Fundus photo, FOV: 45 degrees: 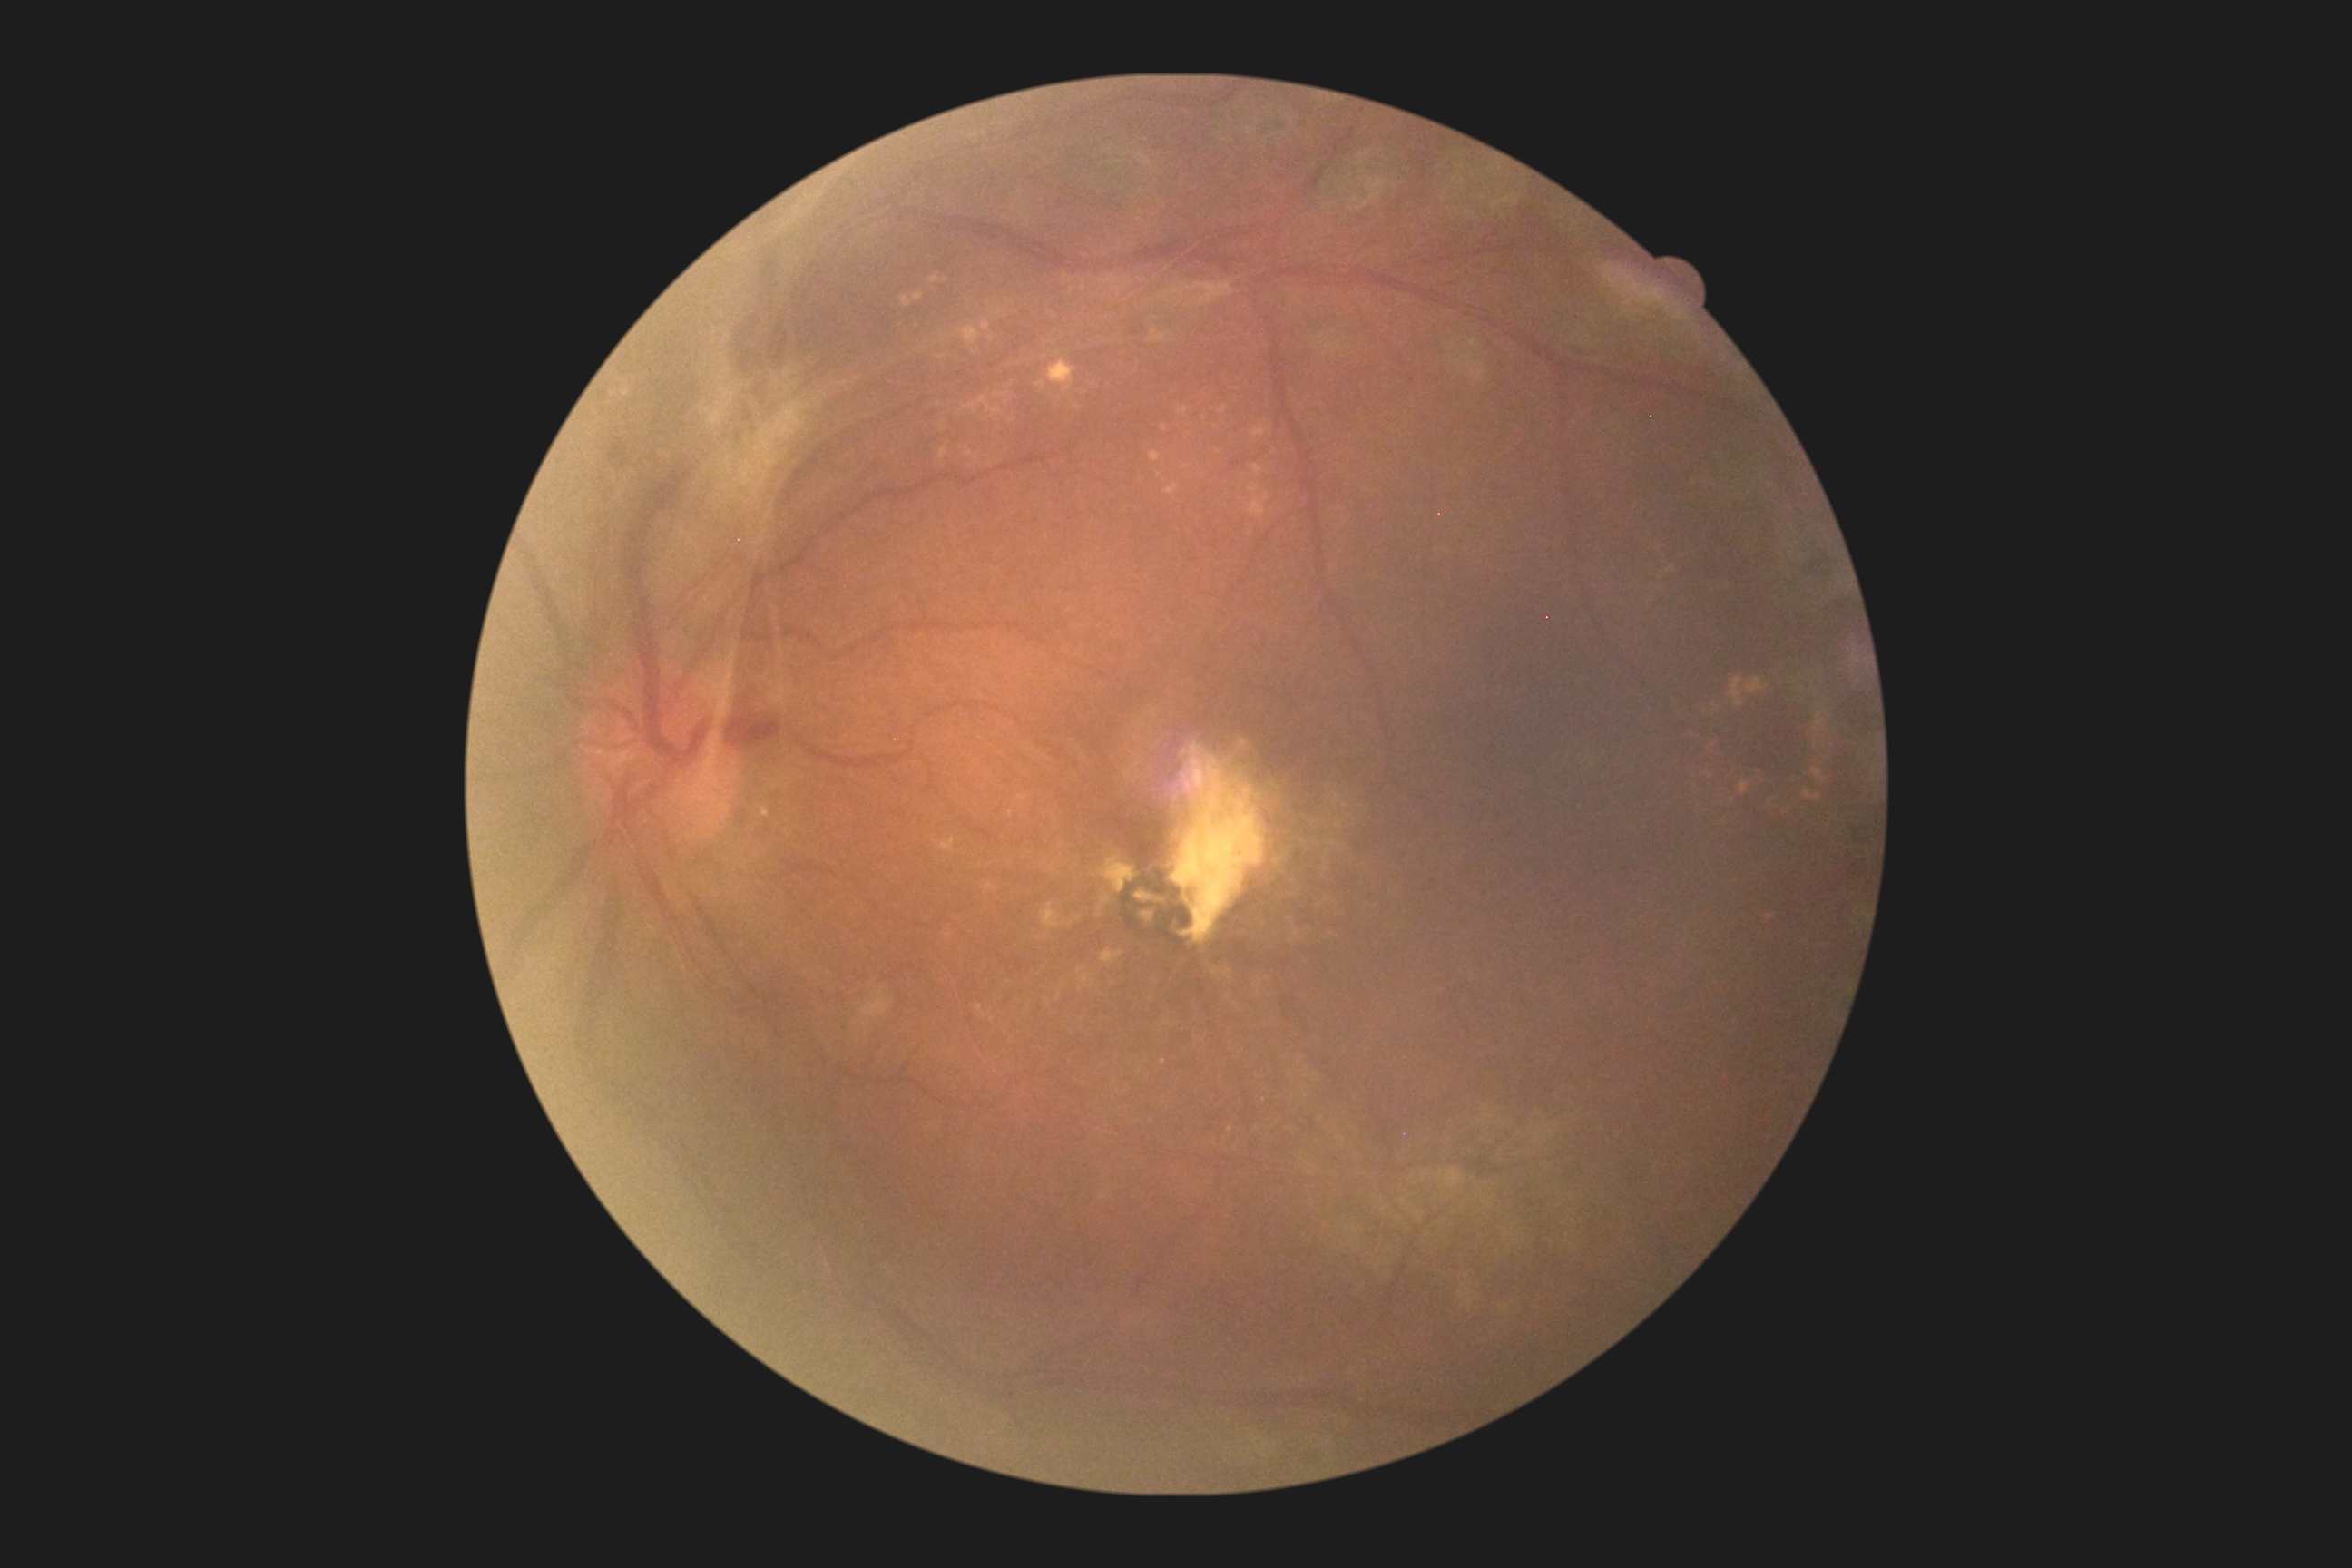
Diabetic retinopathy: grade 4.